Color fundus photograph:
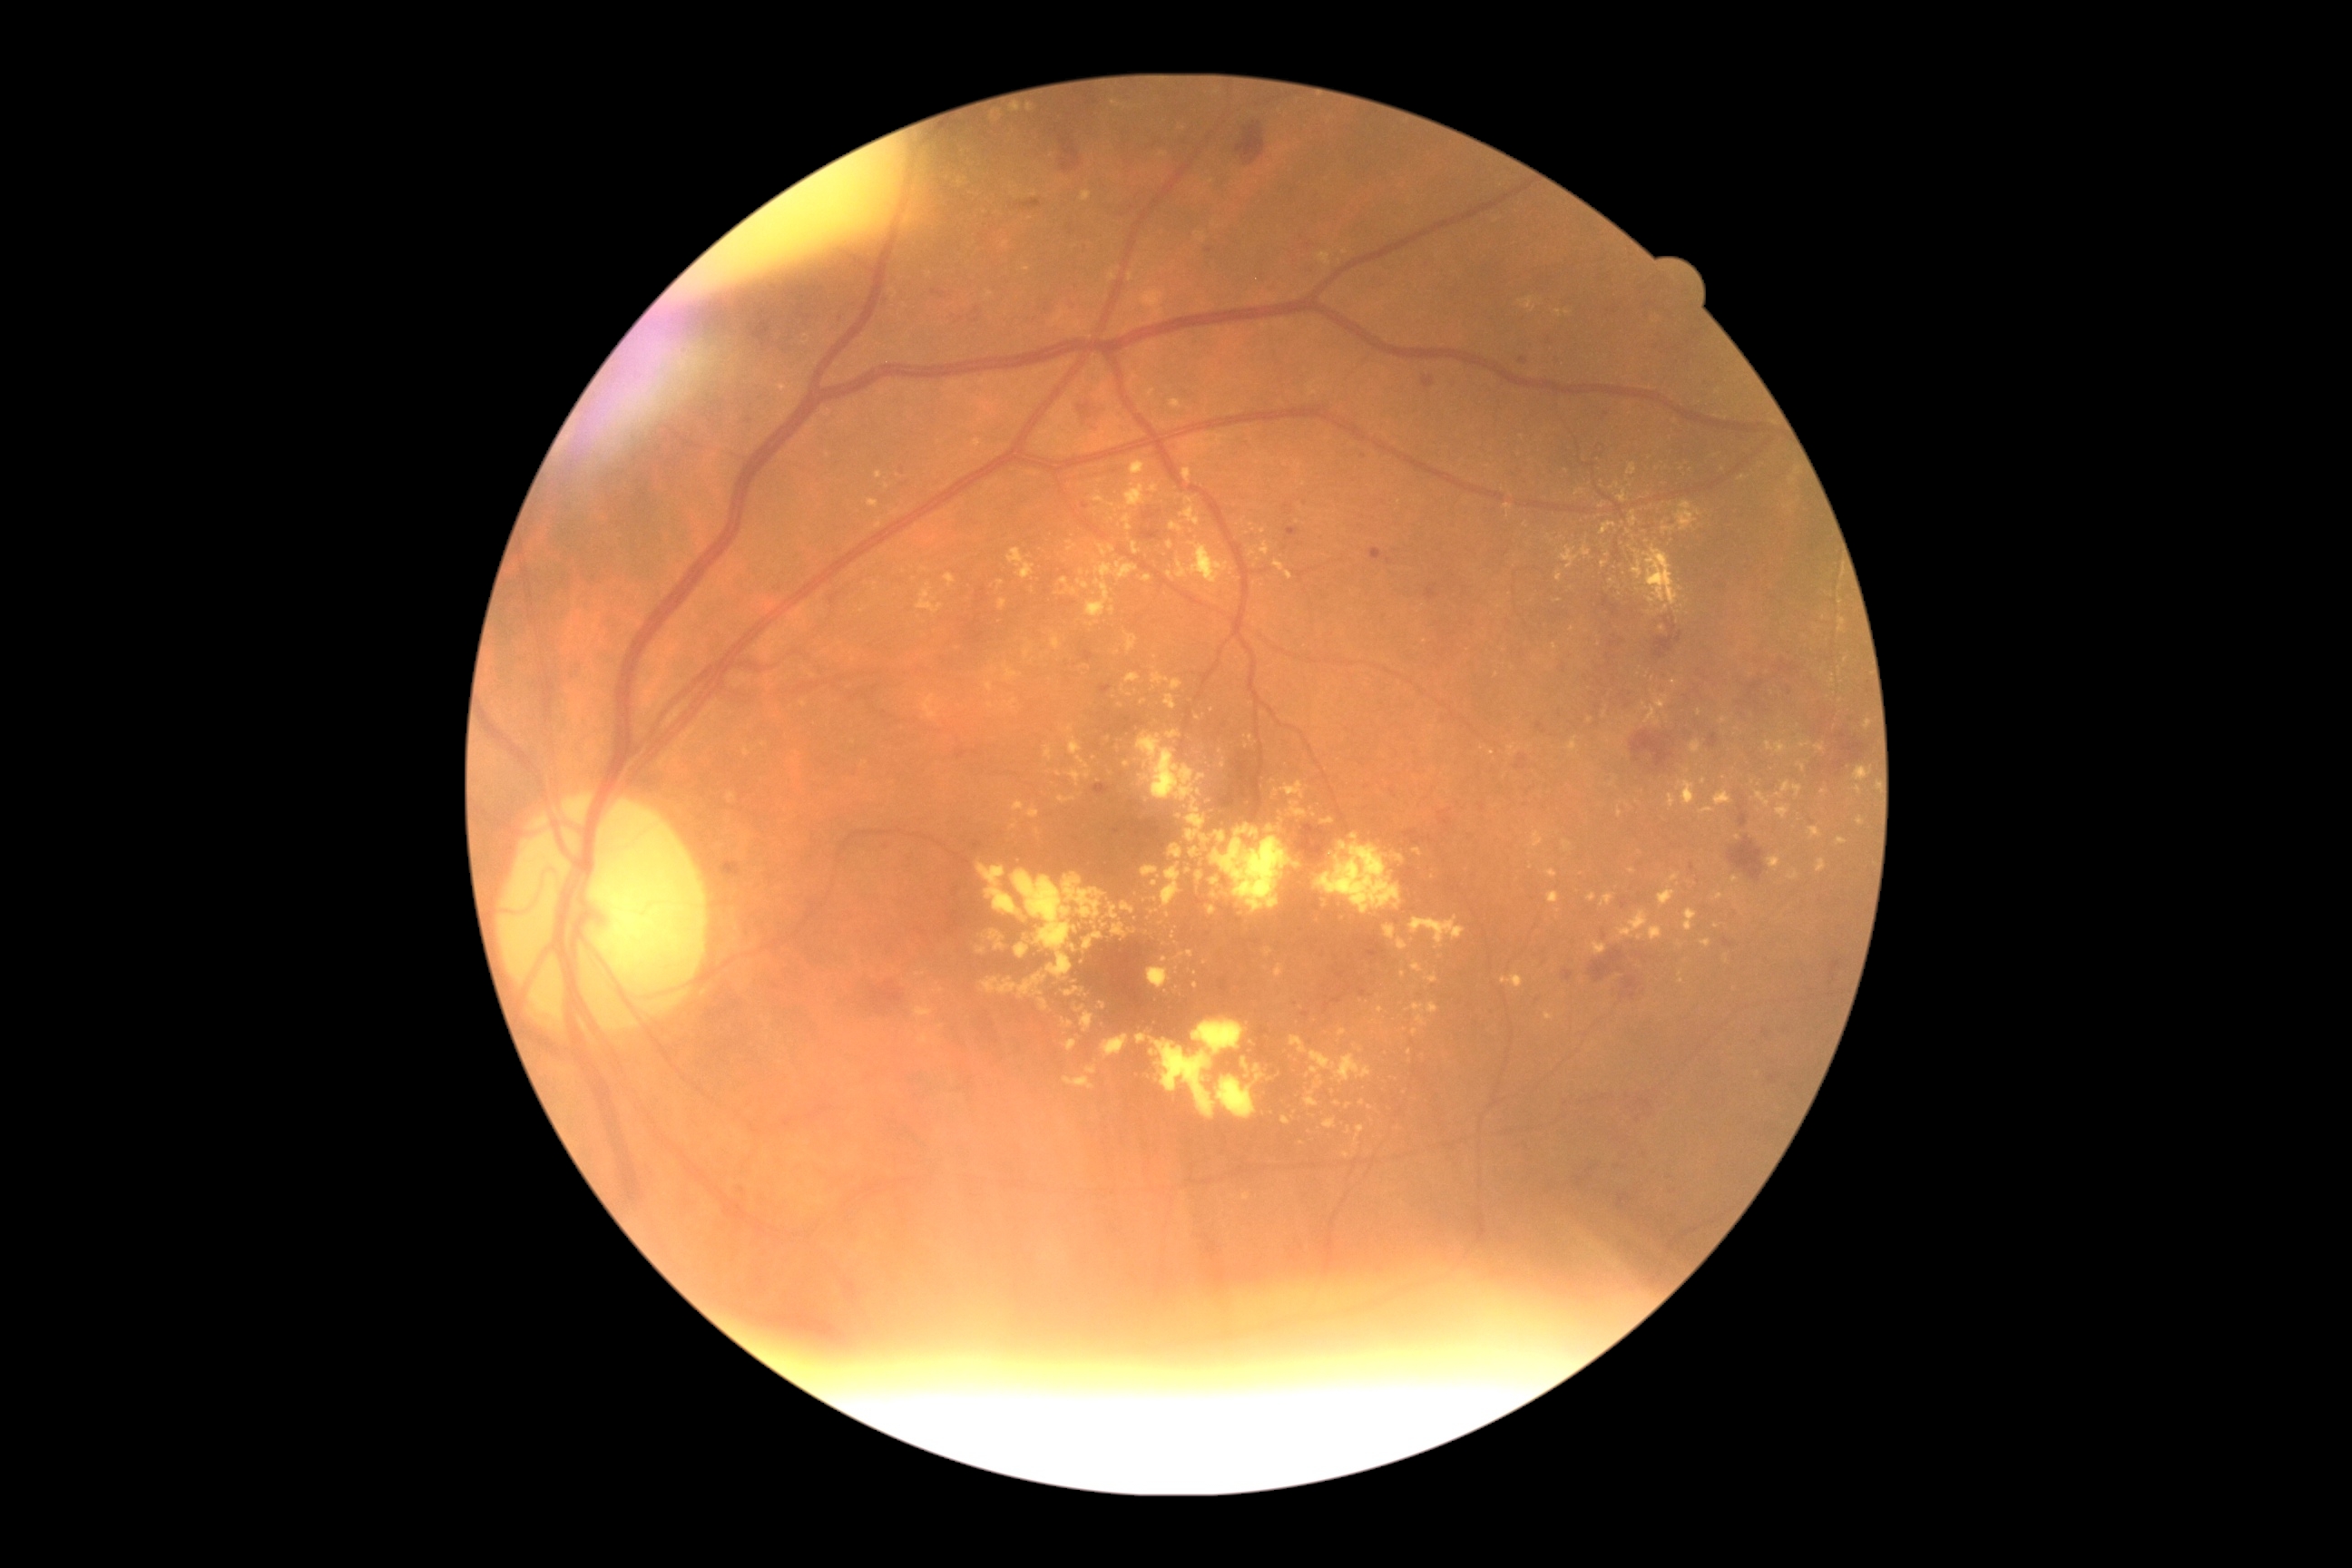

DR grade is 2/4
A subset of detected lesions:
EXs (more not shown): (1553,643,1558,651); (1095,560,1139,582); (1678,781,1696,807); (1130,460,1146,476); (1413,848,1422,858); (1066,727,1073,736); (1701,939,1712,948); (1649,926,1661,941); (1242,1193,1251,1199); (1656,466,1667,476); (1427,1004,1440,1015); (1260,542,1271,556)
Smaller EXs around 1075/592; 1221/751; 1682/983; 993/116; 1681/589; 1184/1195; 1700/713